FOV: 45 degrees. 2212 x 1659 pixels
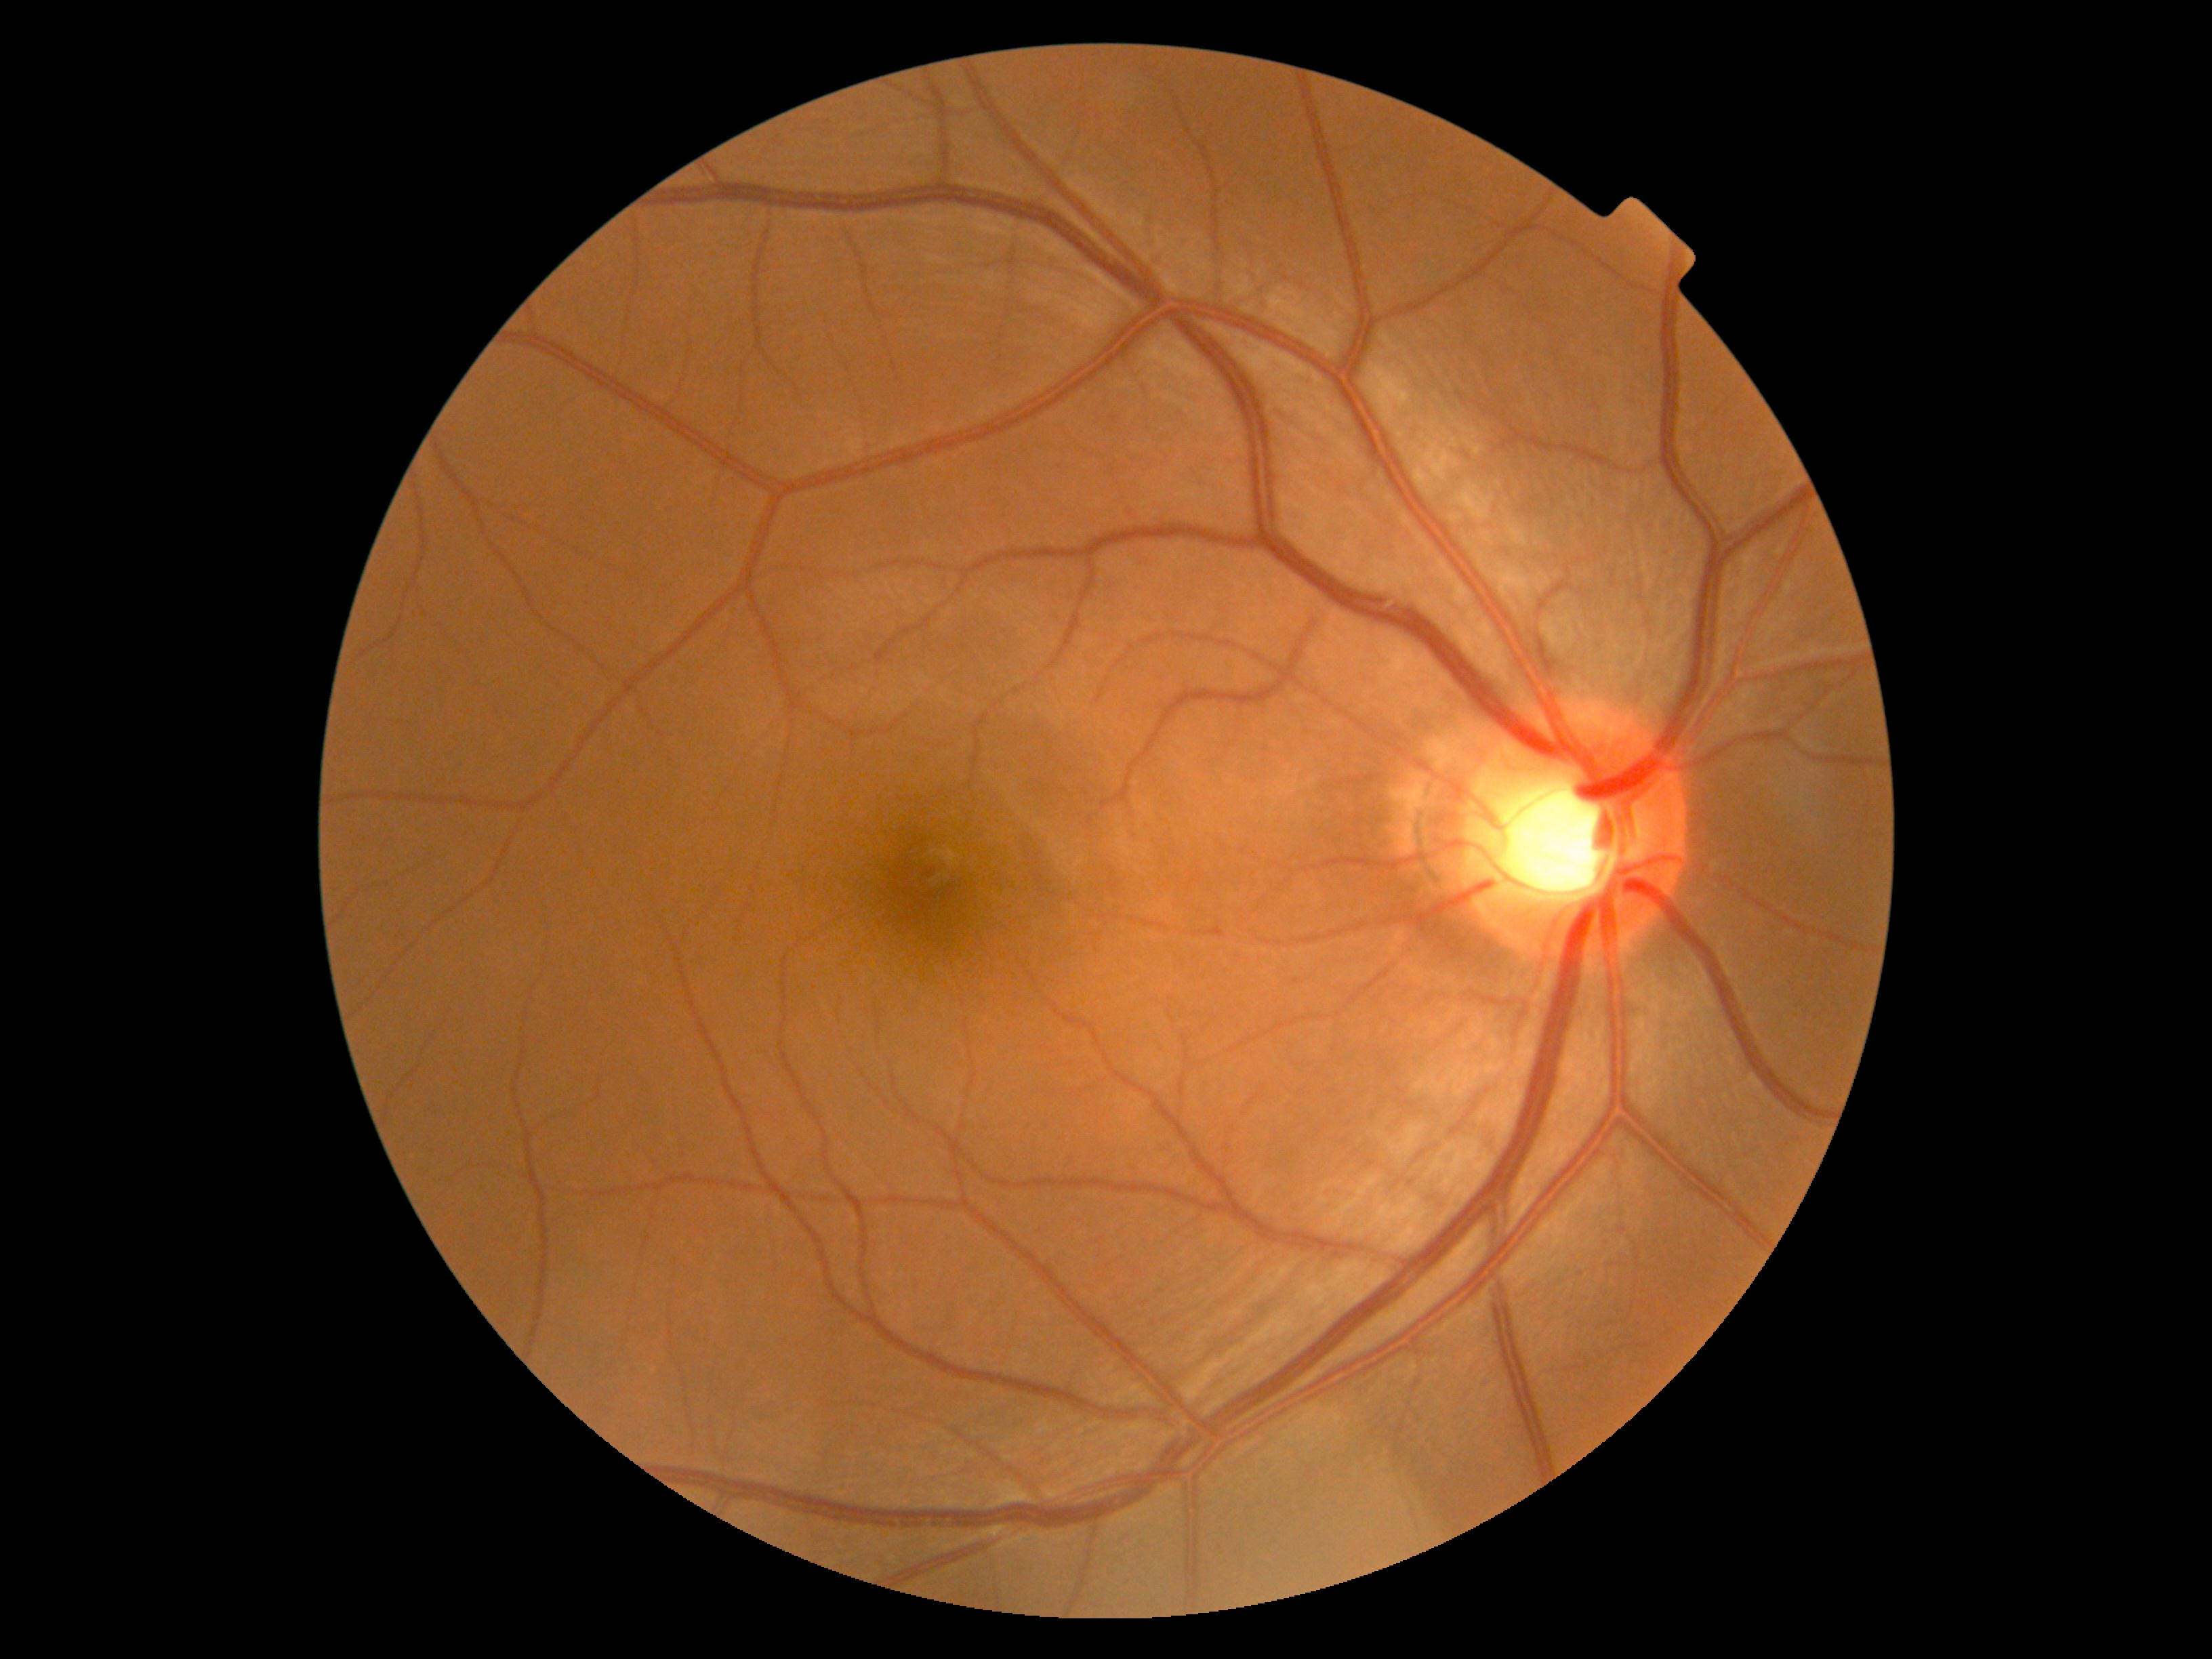 No DR findings. DR is 0/4.